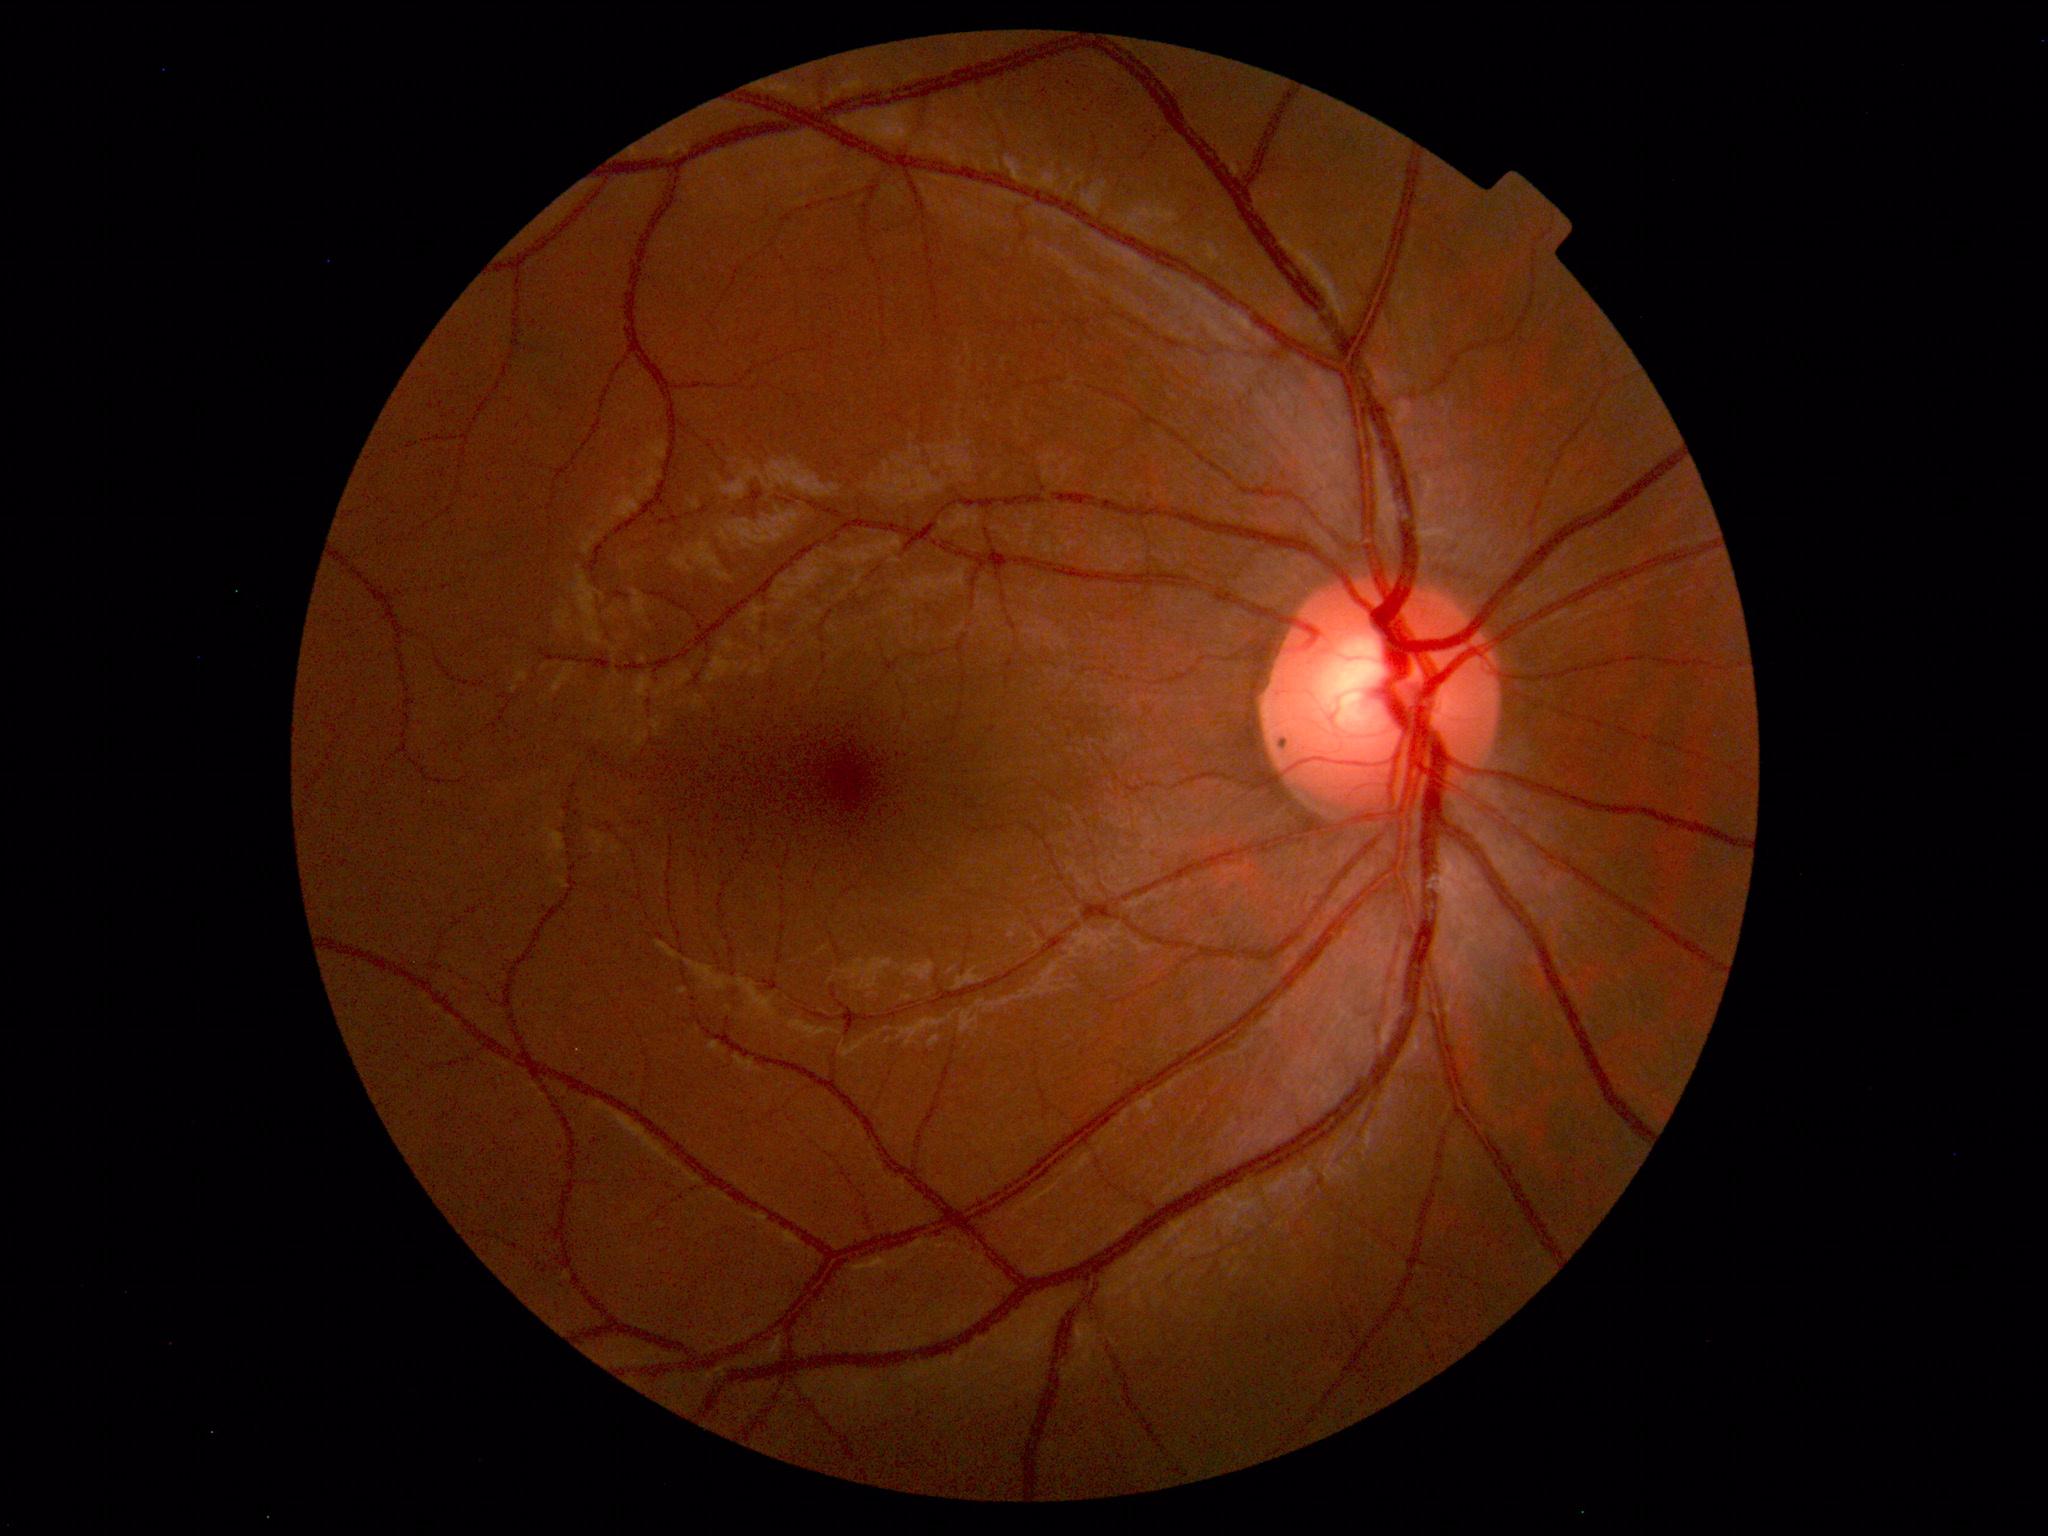 Normal fundus appearance.